Image size 768x576.
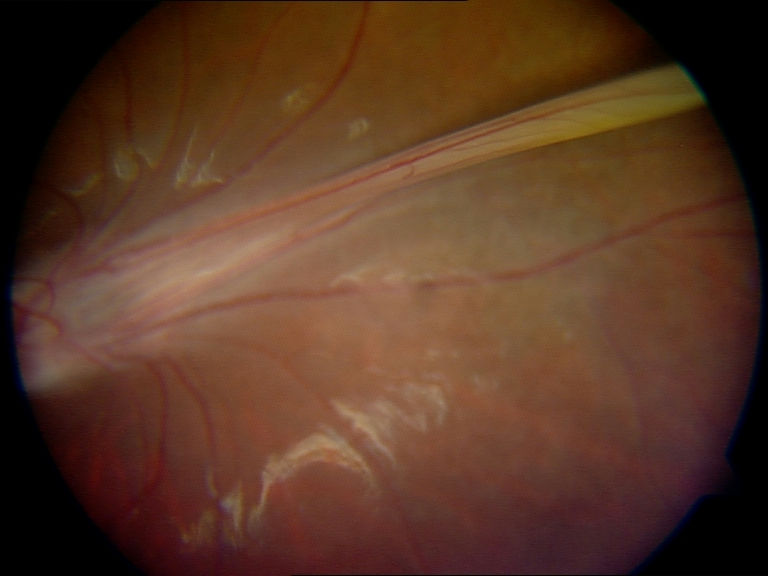
Diagnosis: dragged disc. Defined by temporal vascular straightening, retinal fold, or vitreous bands extending from the peripheral retina to the disc.